Pediatric wide-field fundus photograph
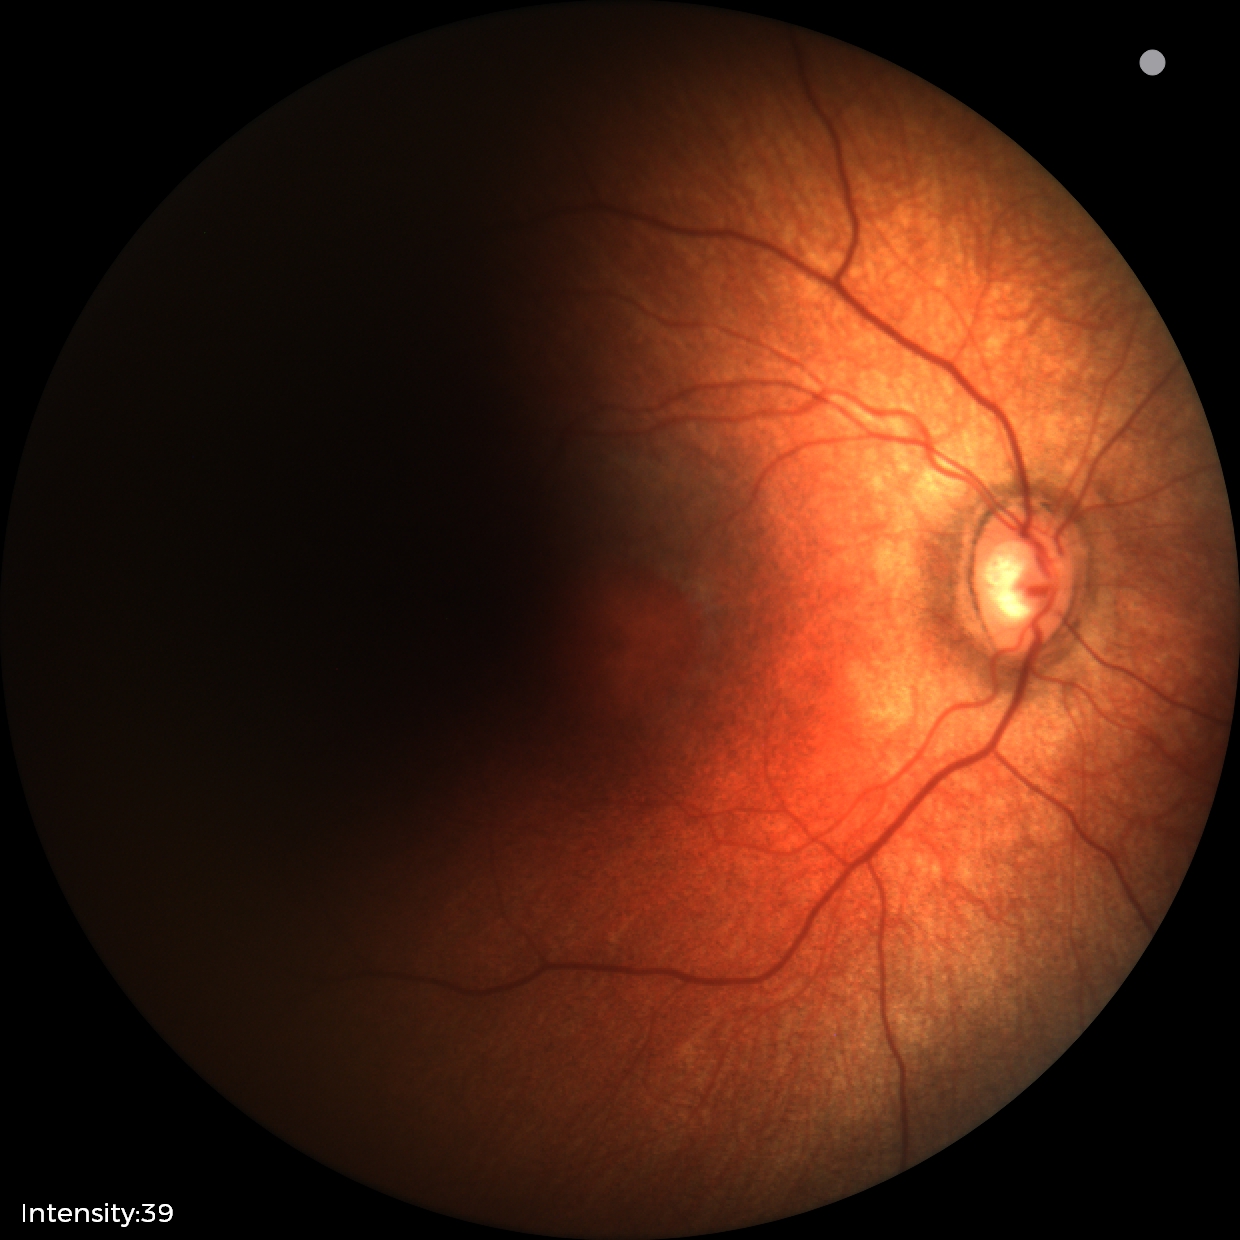

Screening diagnosis: physiological finding.